CFP:
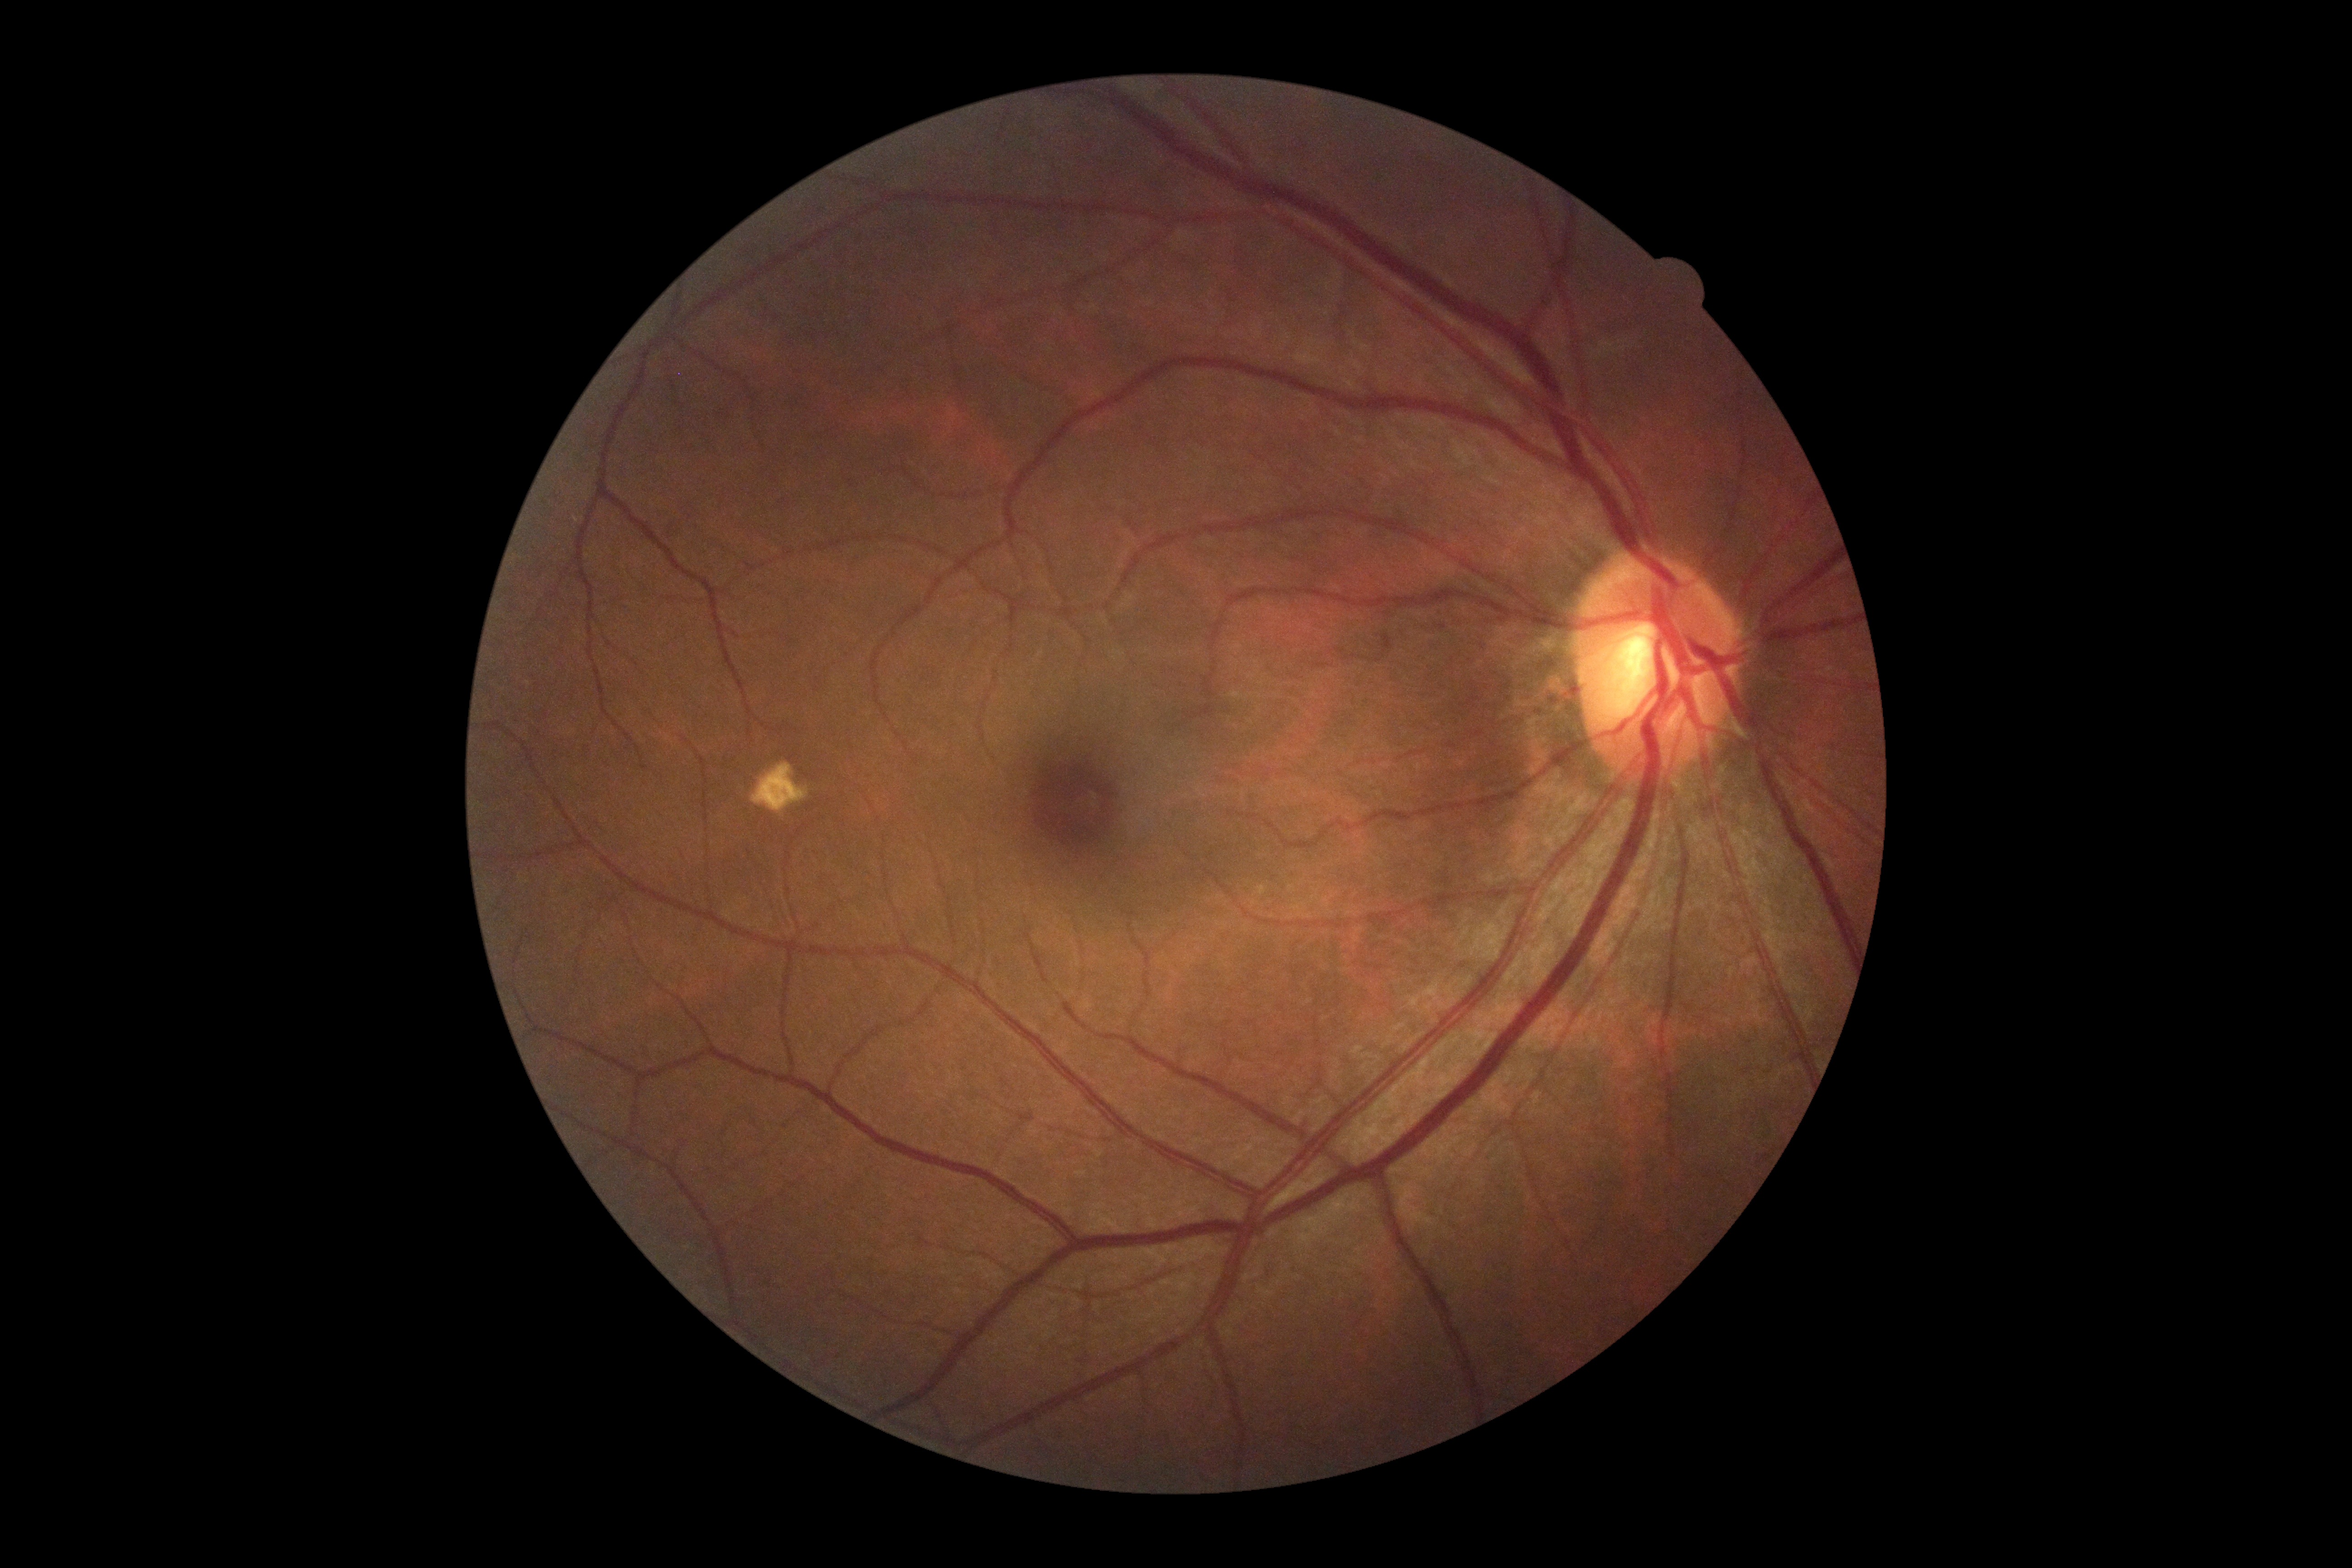

Diabetic retinopathy (DR): grade 0 (no apparent retinopathy). No apparent diabetic retinopathy.